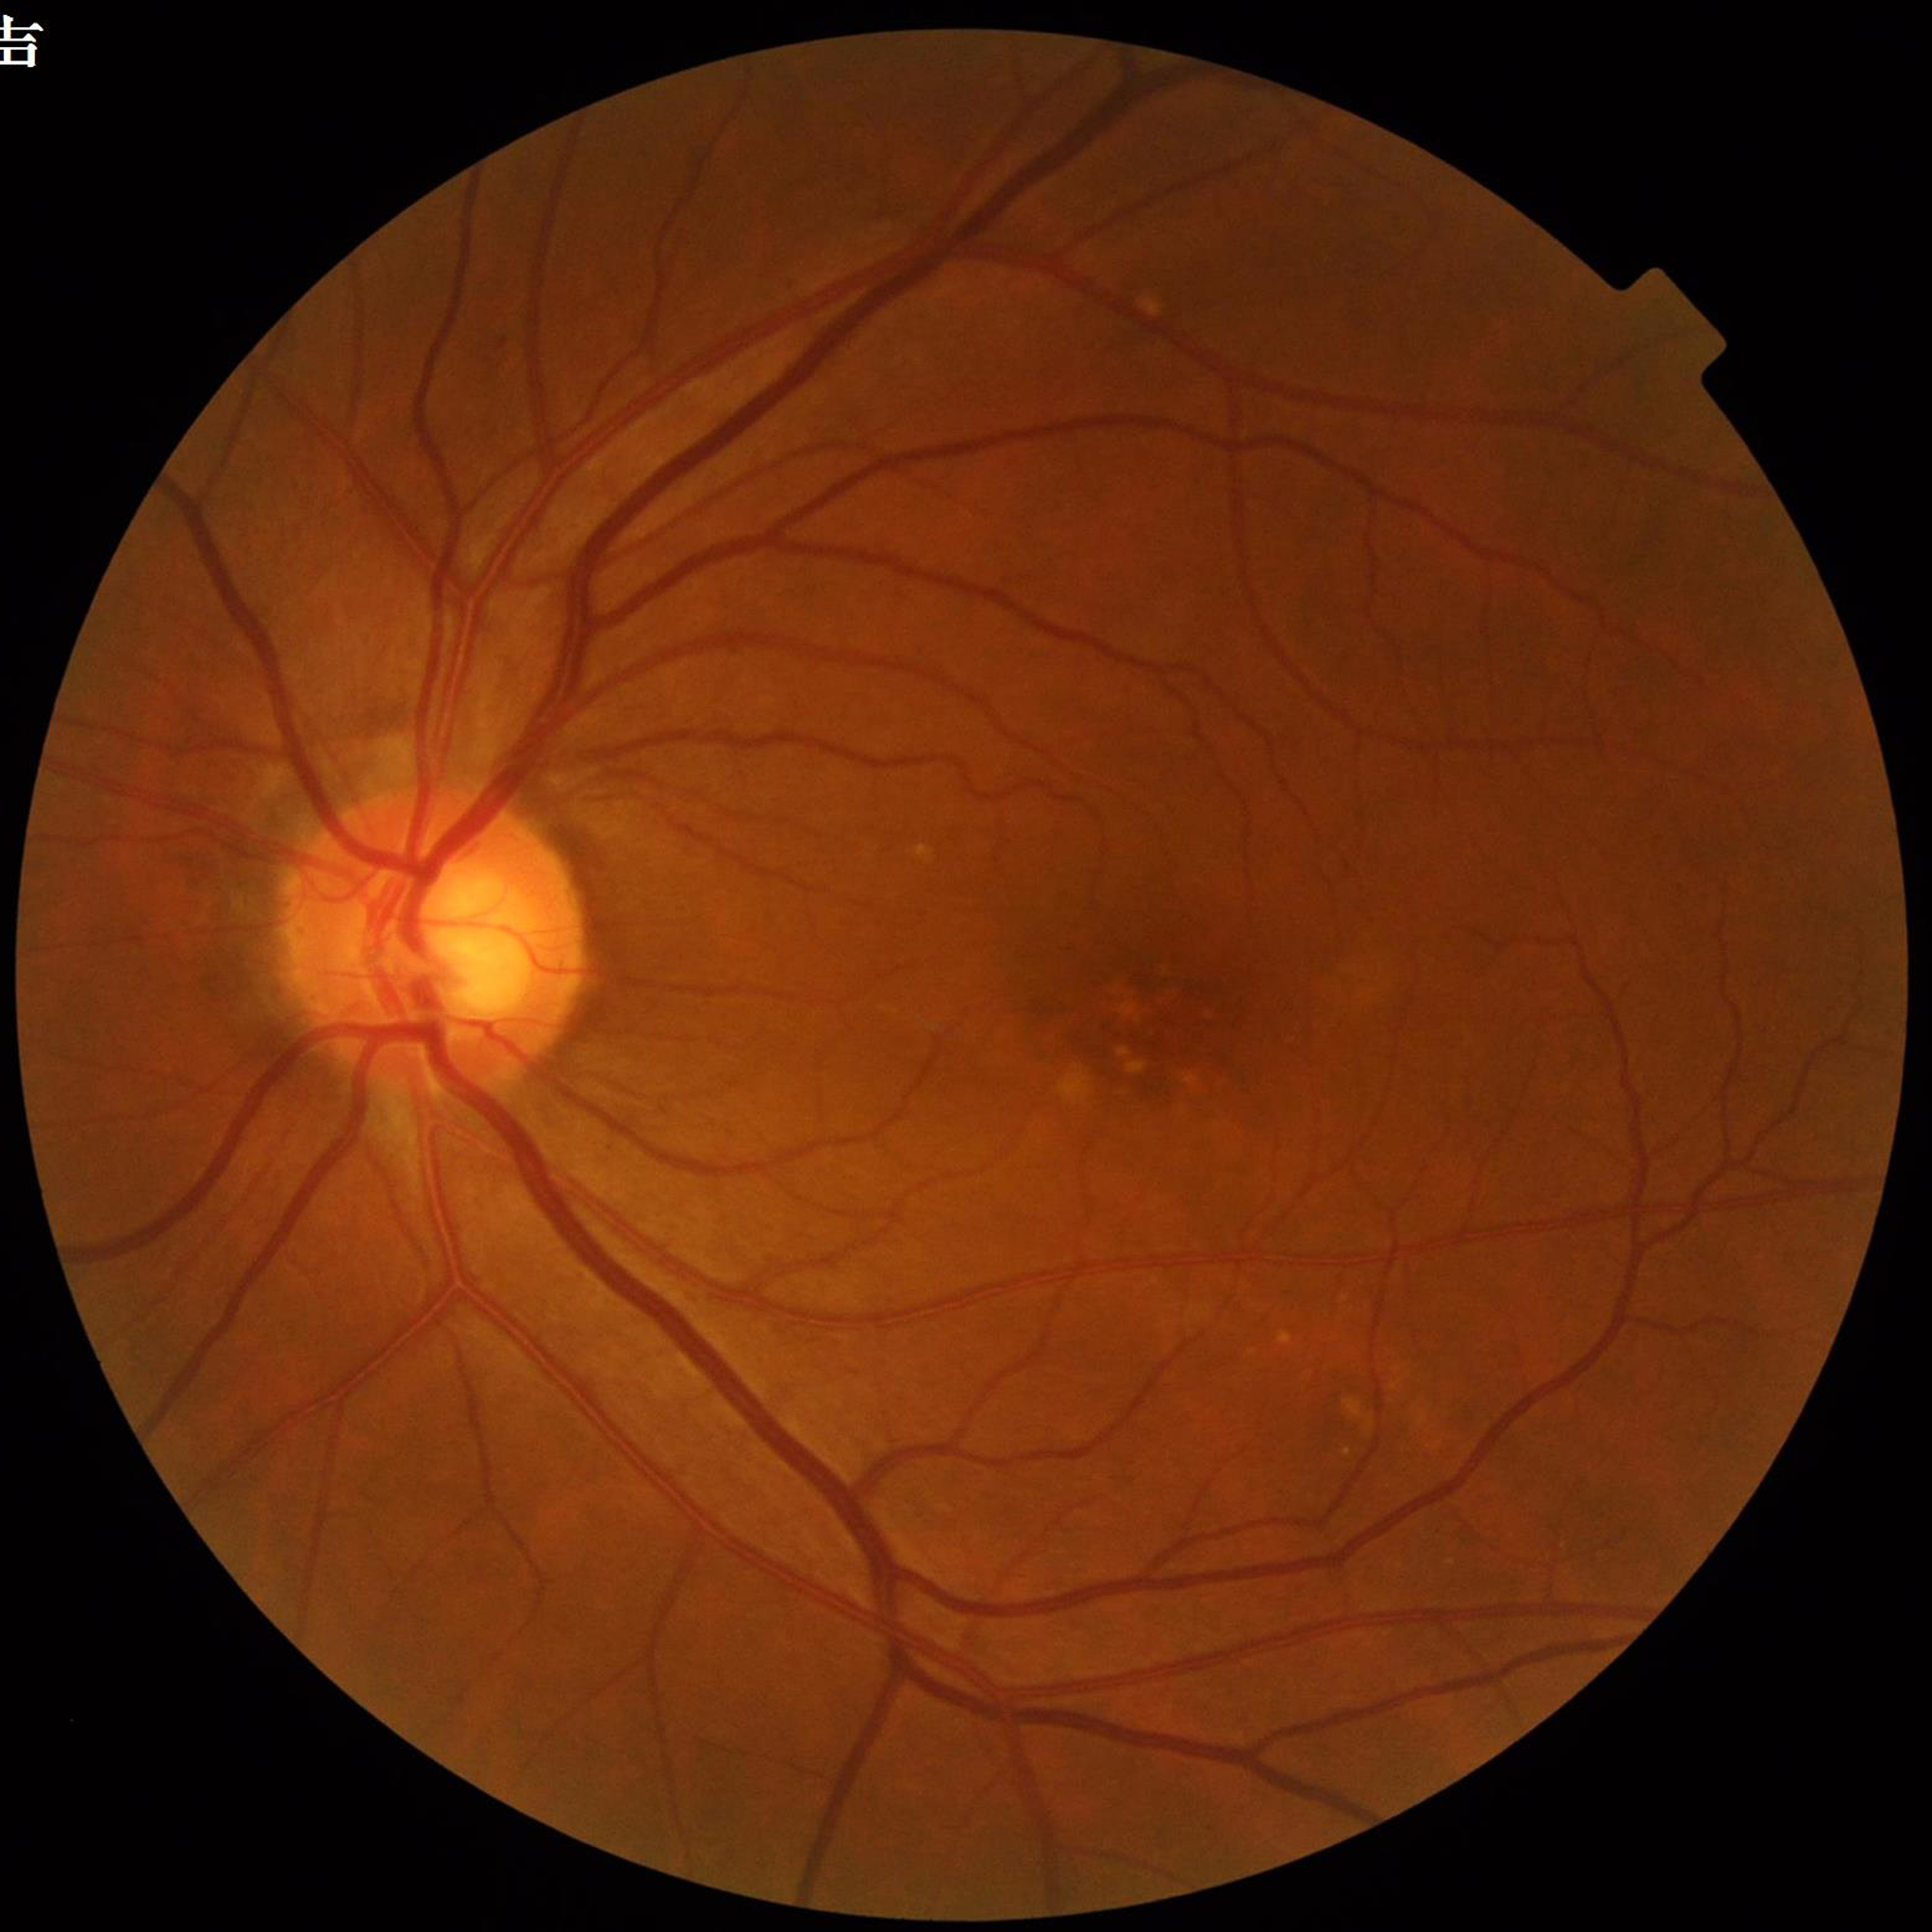
Color fundus photograph from a patient diagnosed with age-related macular degeneration.